1659x2212; acquired with a Remidio FOP fundus camera; retinal fundus photograph — 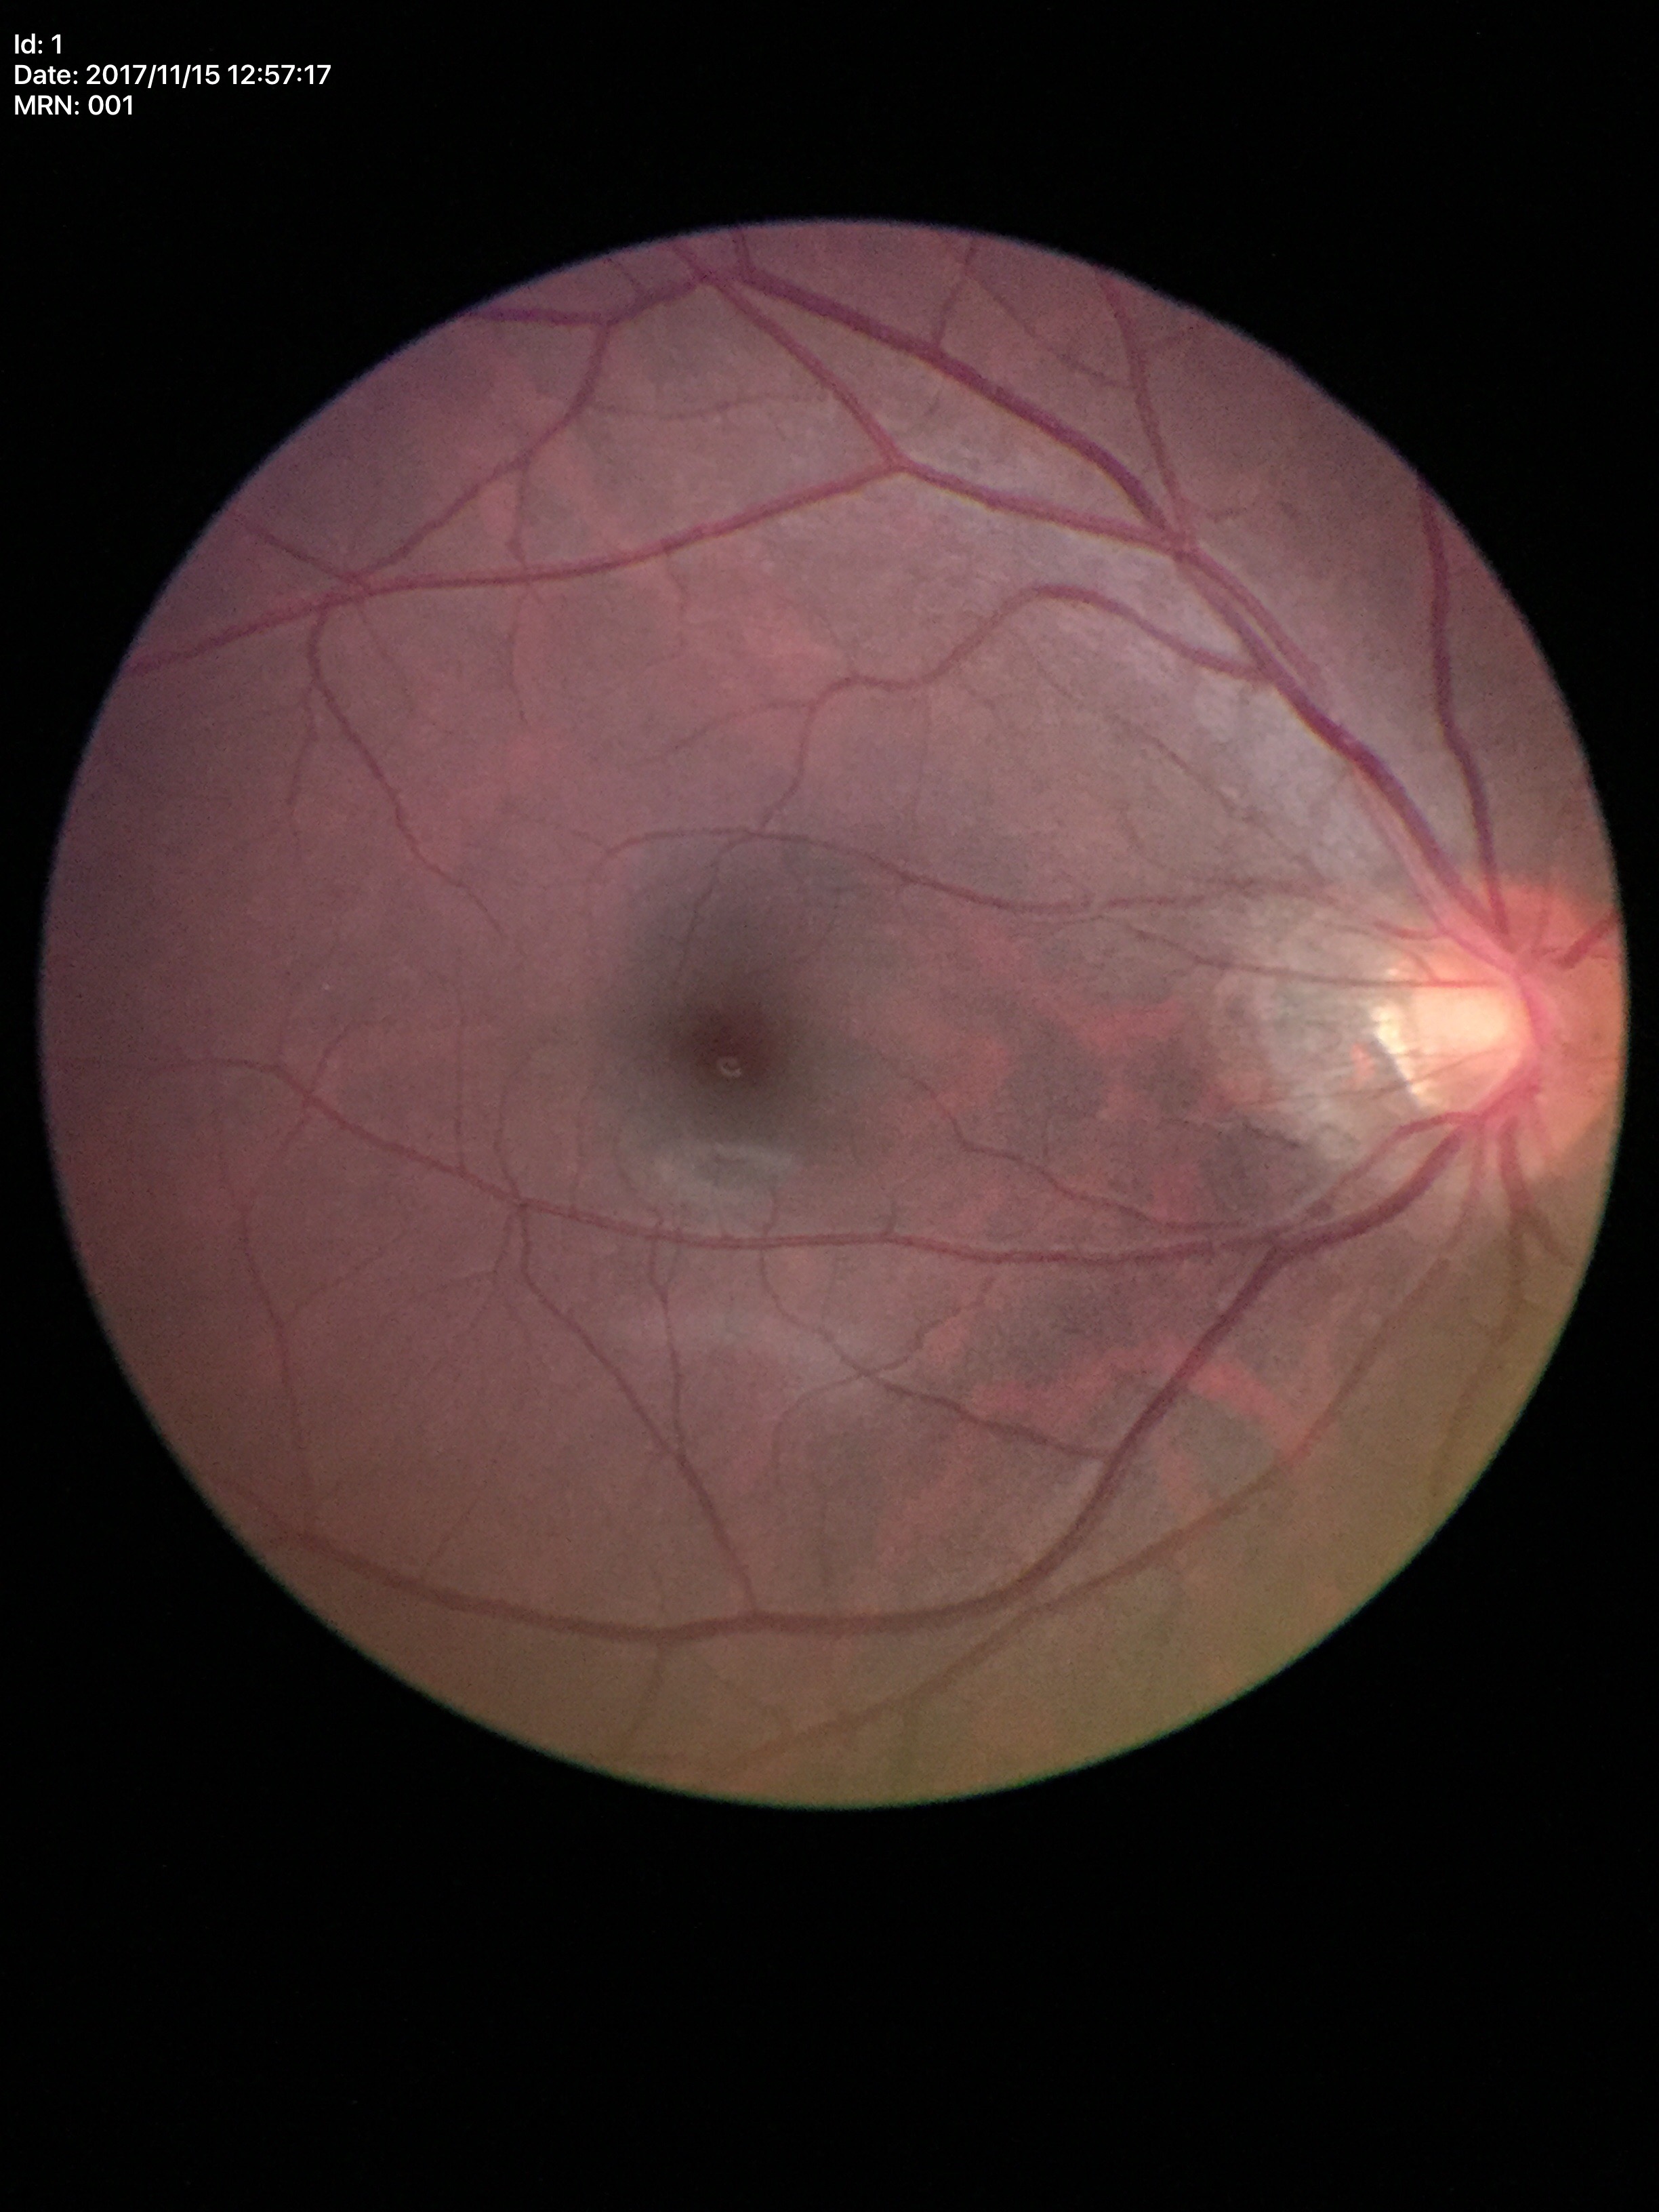
horizontal cup-disc ratio=0.48 | vertical C/D ratio=0.47 | Glaucoma assessment=not suspect (all 5 graders called normal)